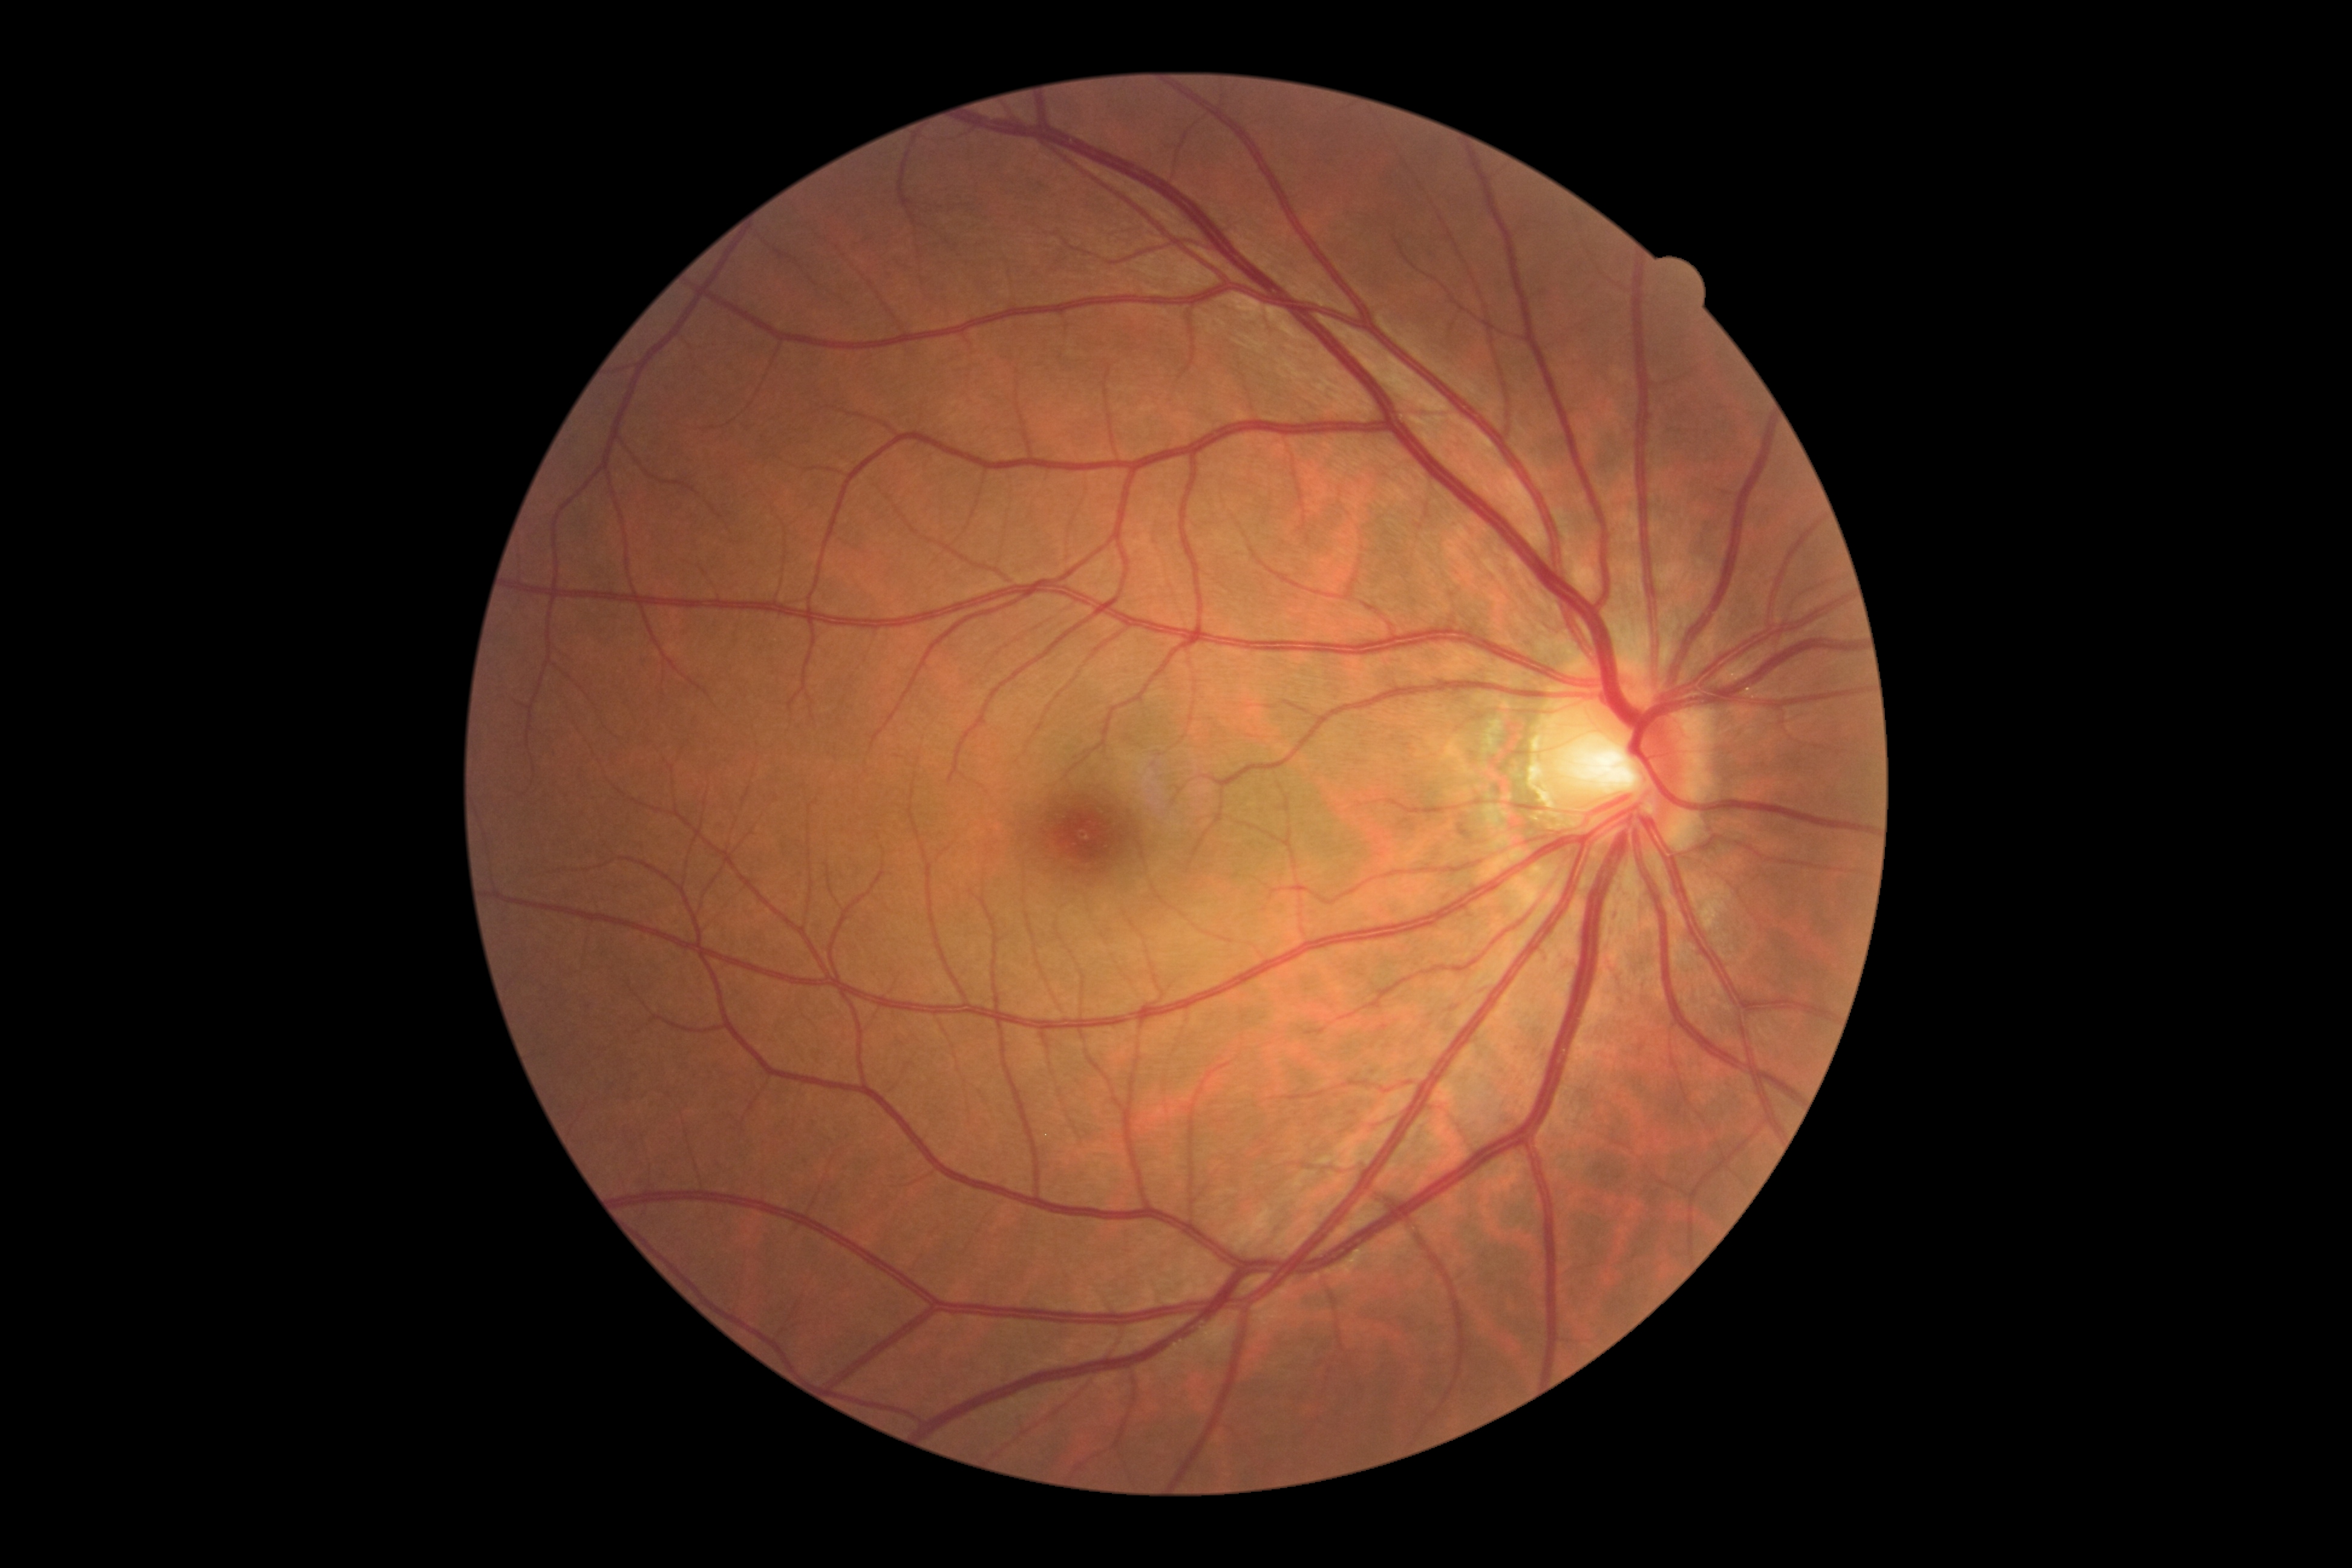

DR grade: 0.